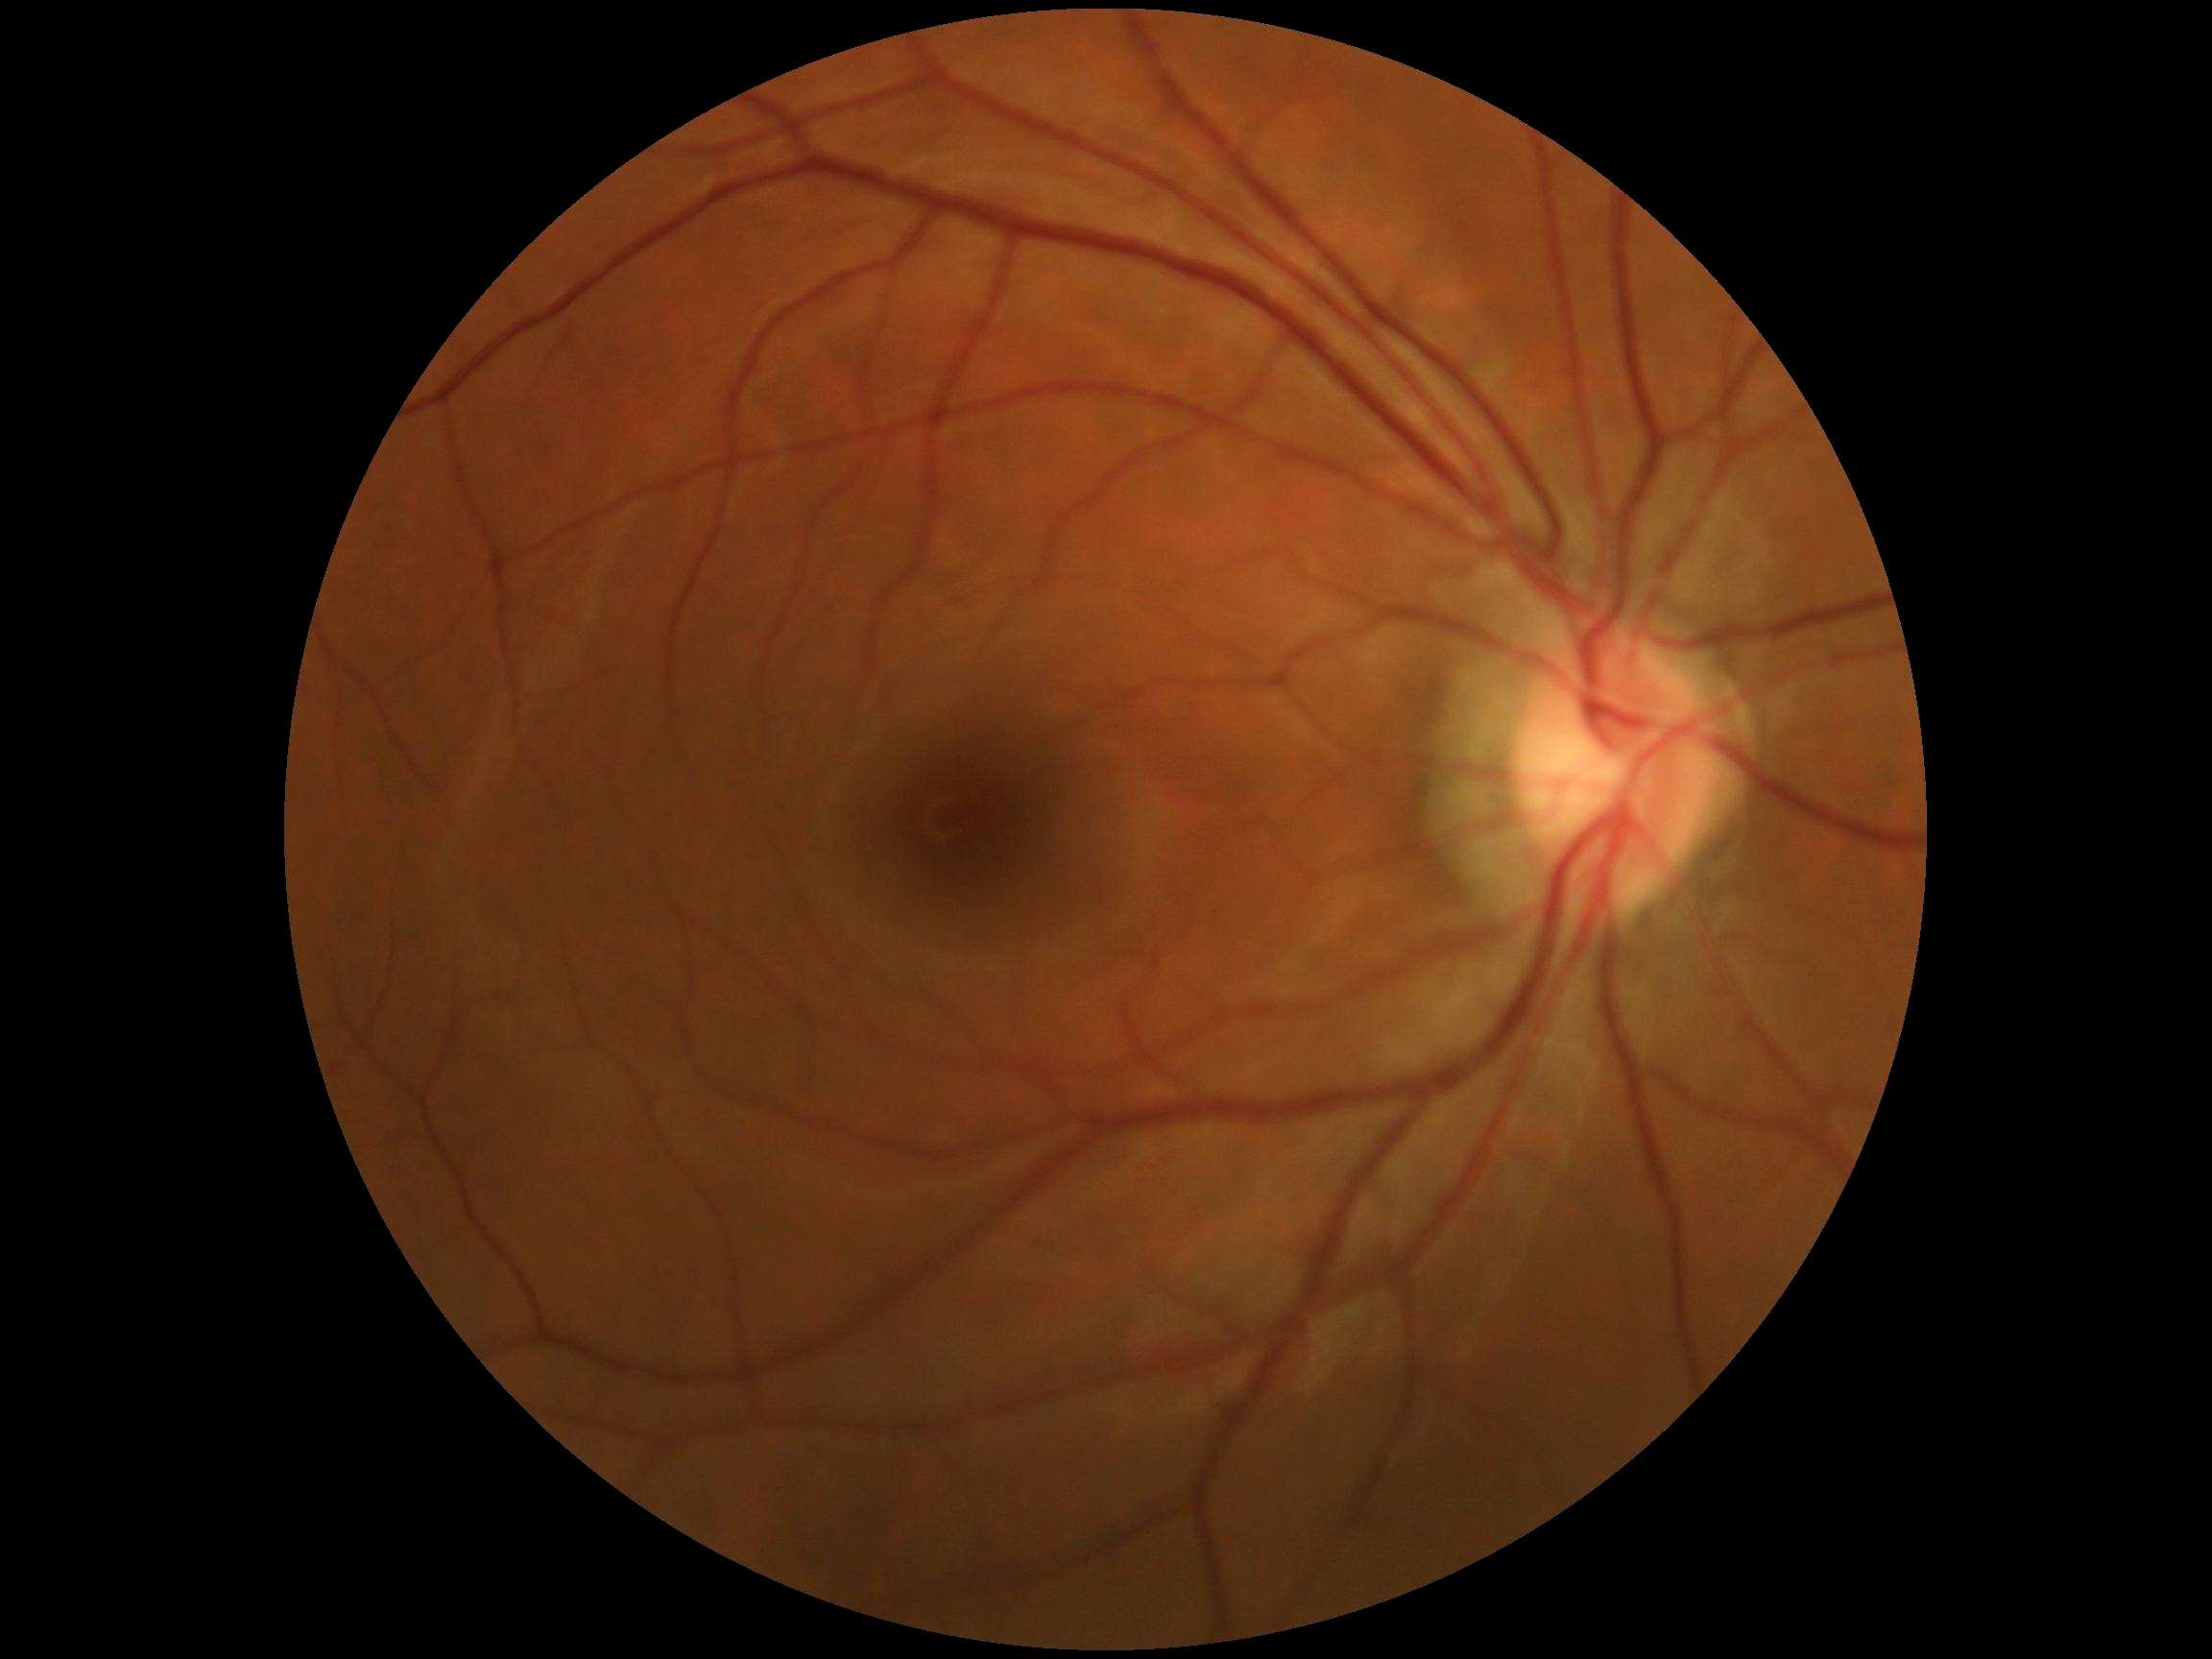
Diabetic retinopathy (DR) is grade 0 (no apparent retinopathy).